Color fundus photograph
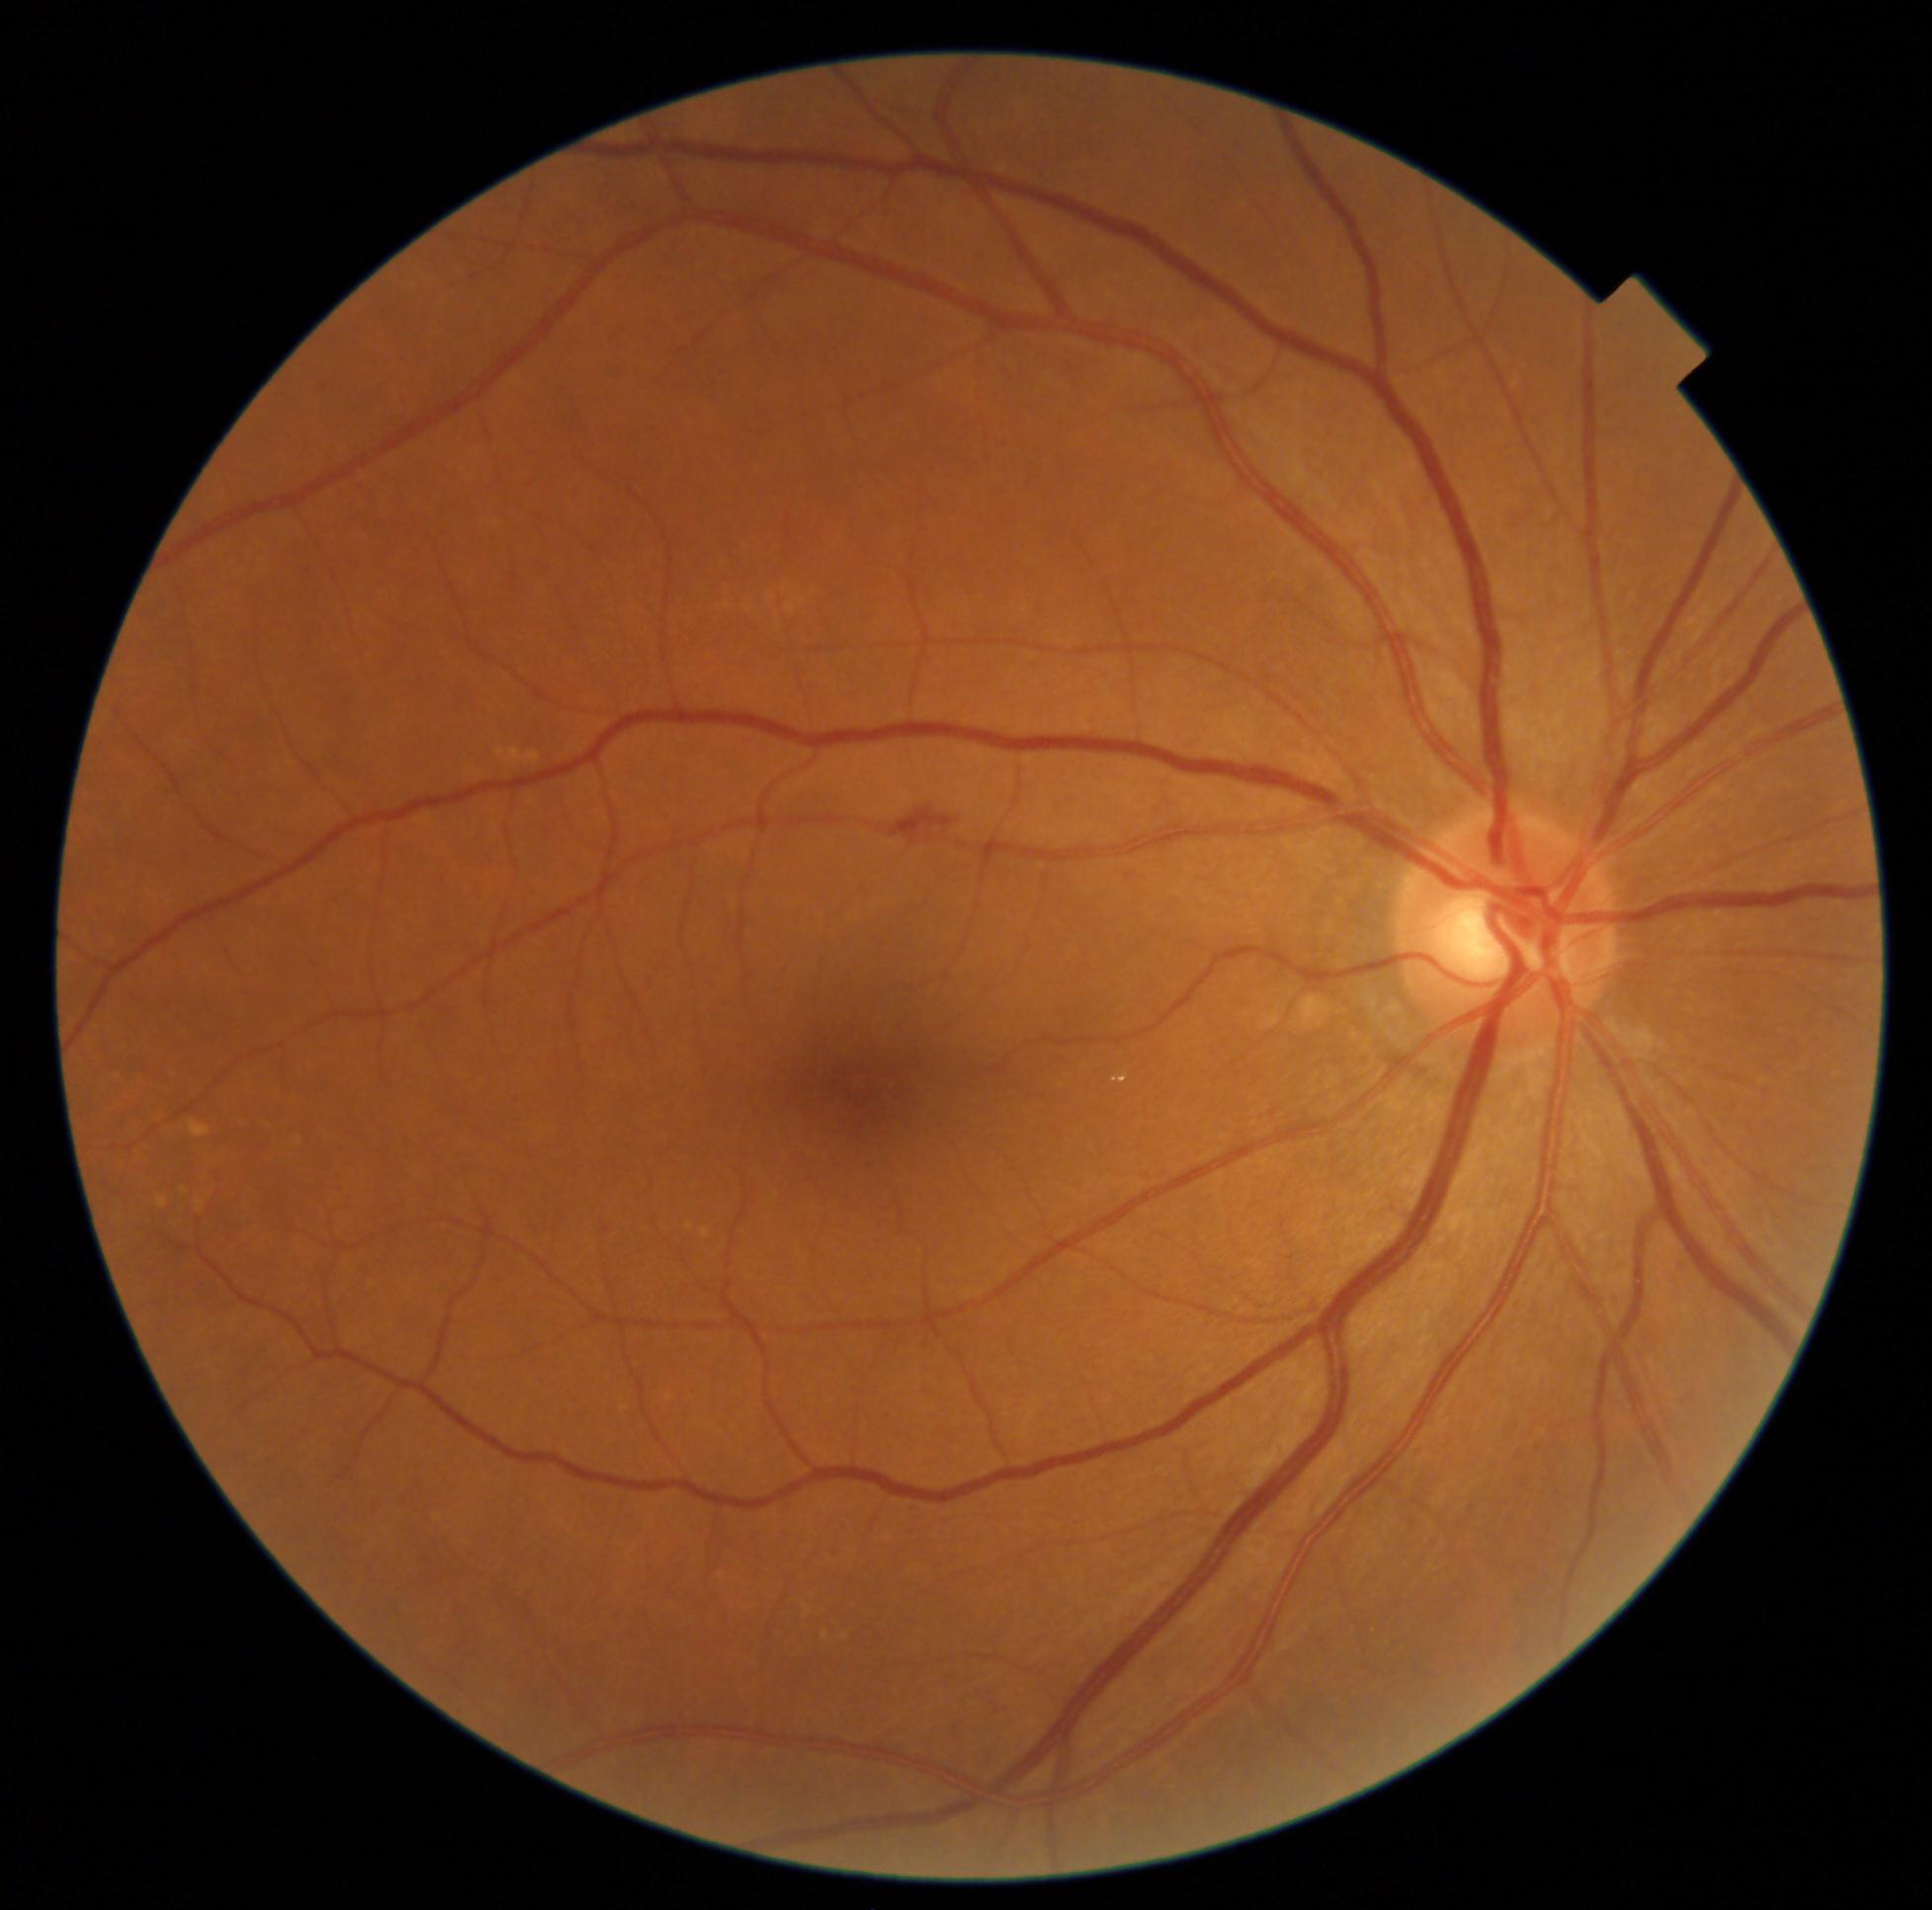

Diabetic retinopathy (DR) is 2/4
hard exudates (EXs): bbox(1112, 1075, 1128, 1084)
hemorrhages (HEs): bbox(889, 808, 958, 846)
soft exudates (SEs): not present
microaneurysms (MAs): not present